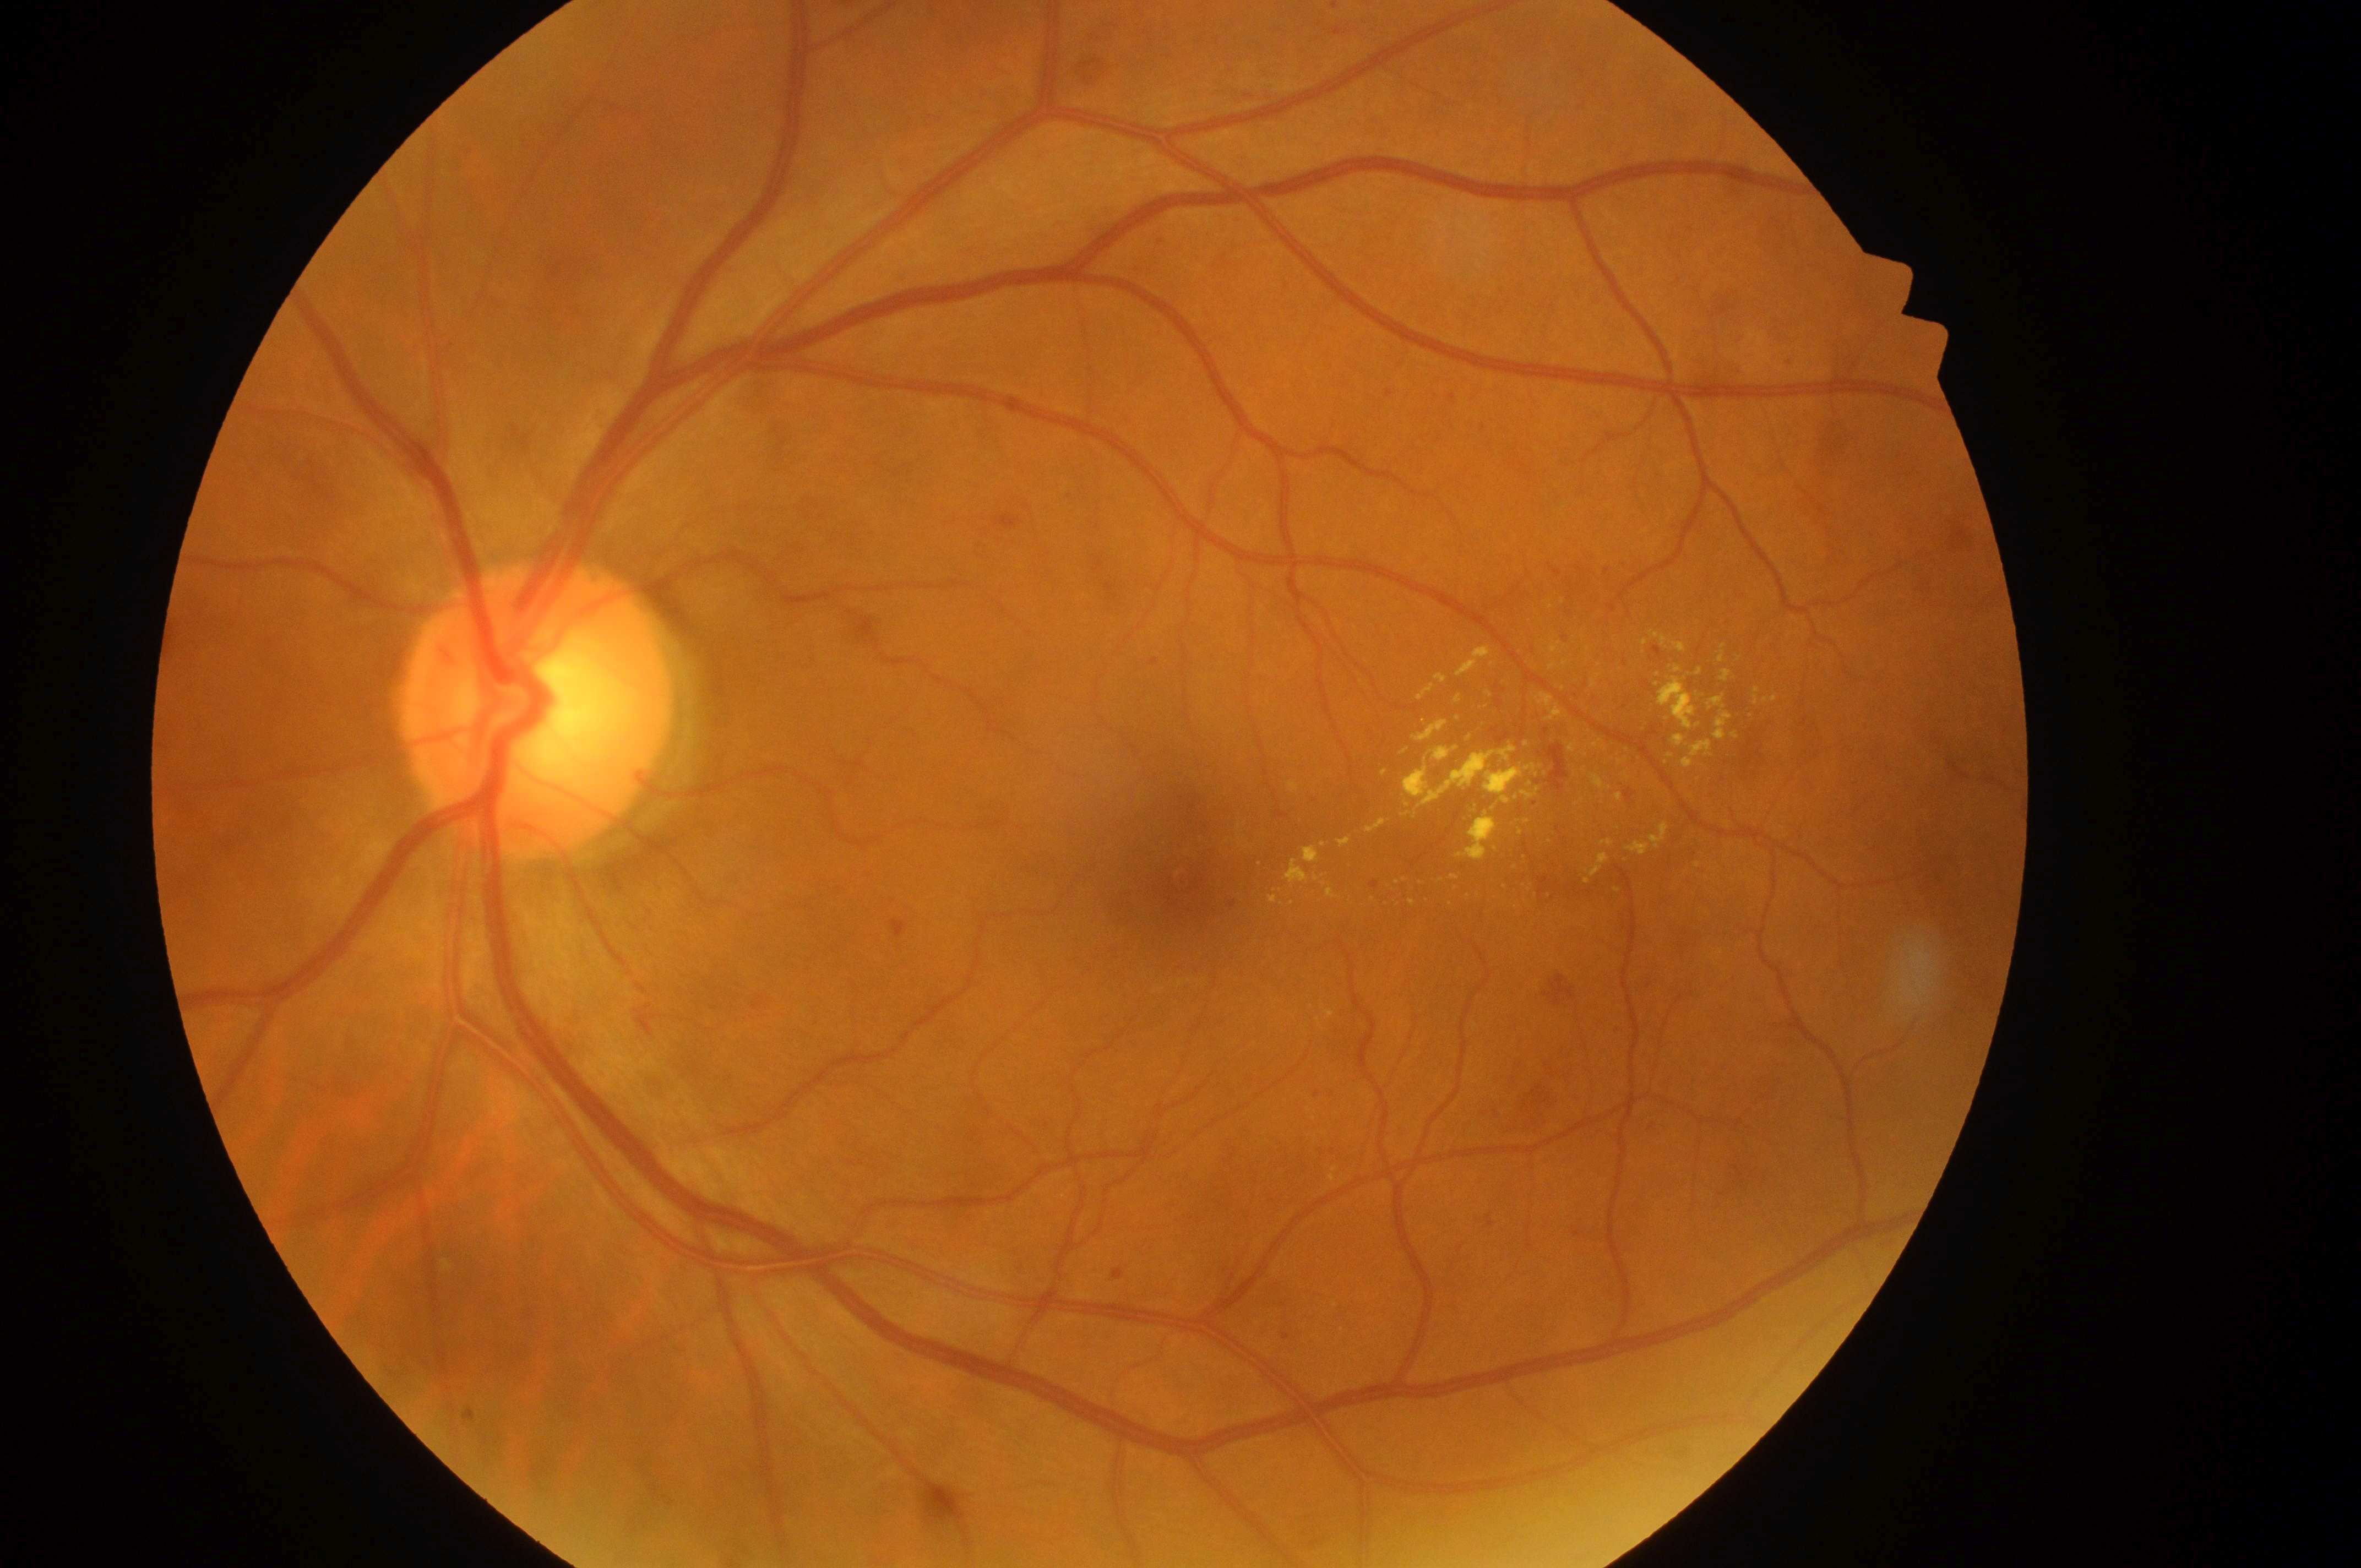 Q: What is the laterality?
A: oculus sinister
Q: Locate the fovea.
A: [1190, 892]
Q: What is the DME risk grade?
A: high risk (2)
Q: Locate the optic disc.
A: [530, 717]
Q: What is the DR grade?
A: moderate non-proliferative diabetic retinopathy (grade 2)